2352x1568px, color fundus image
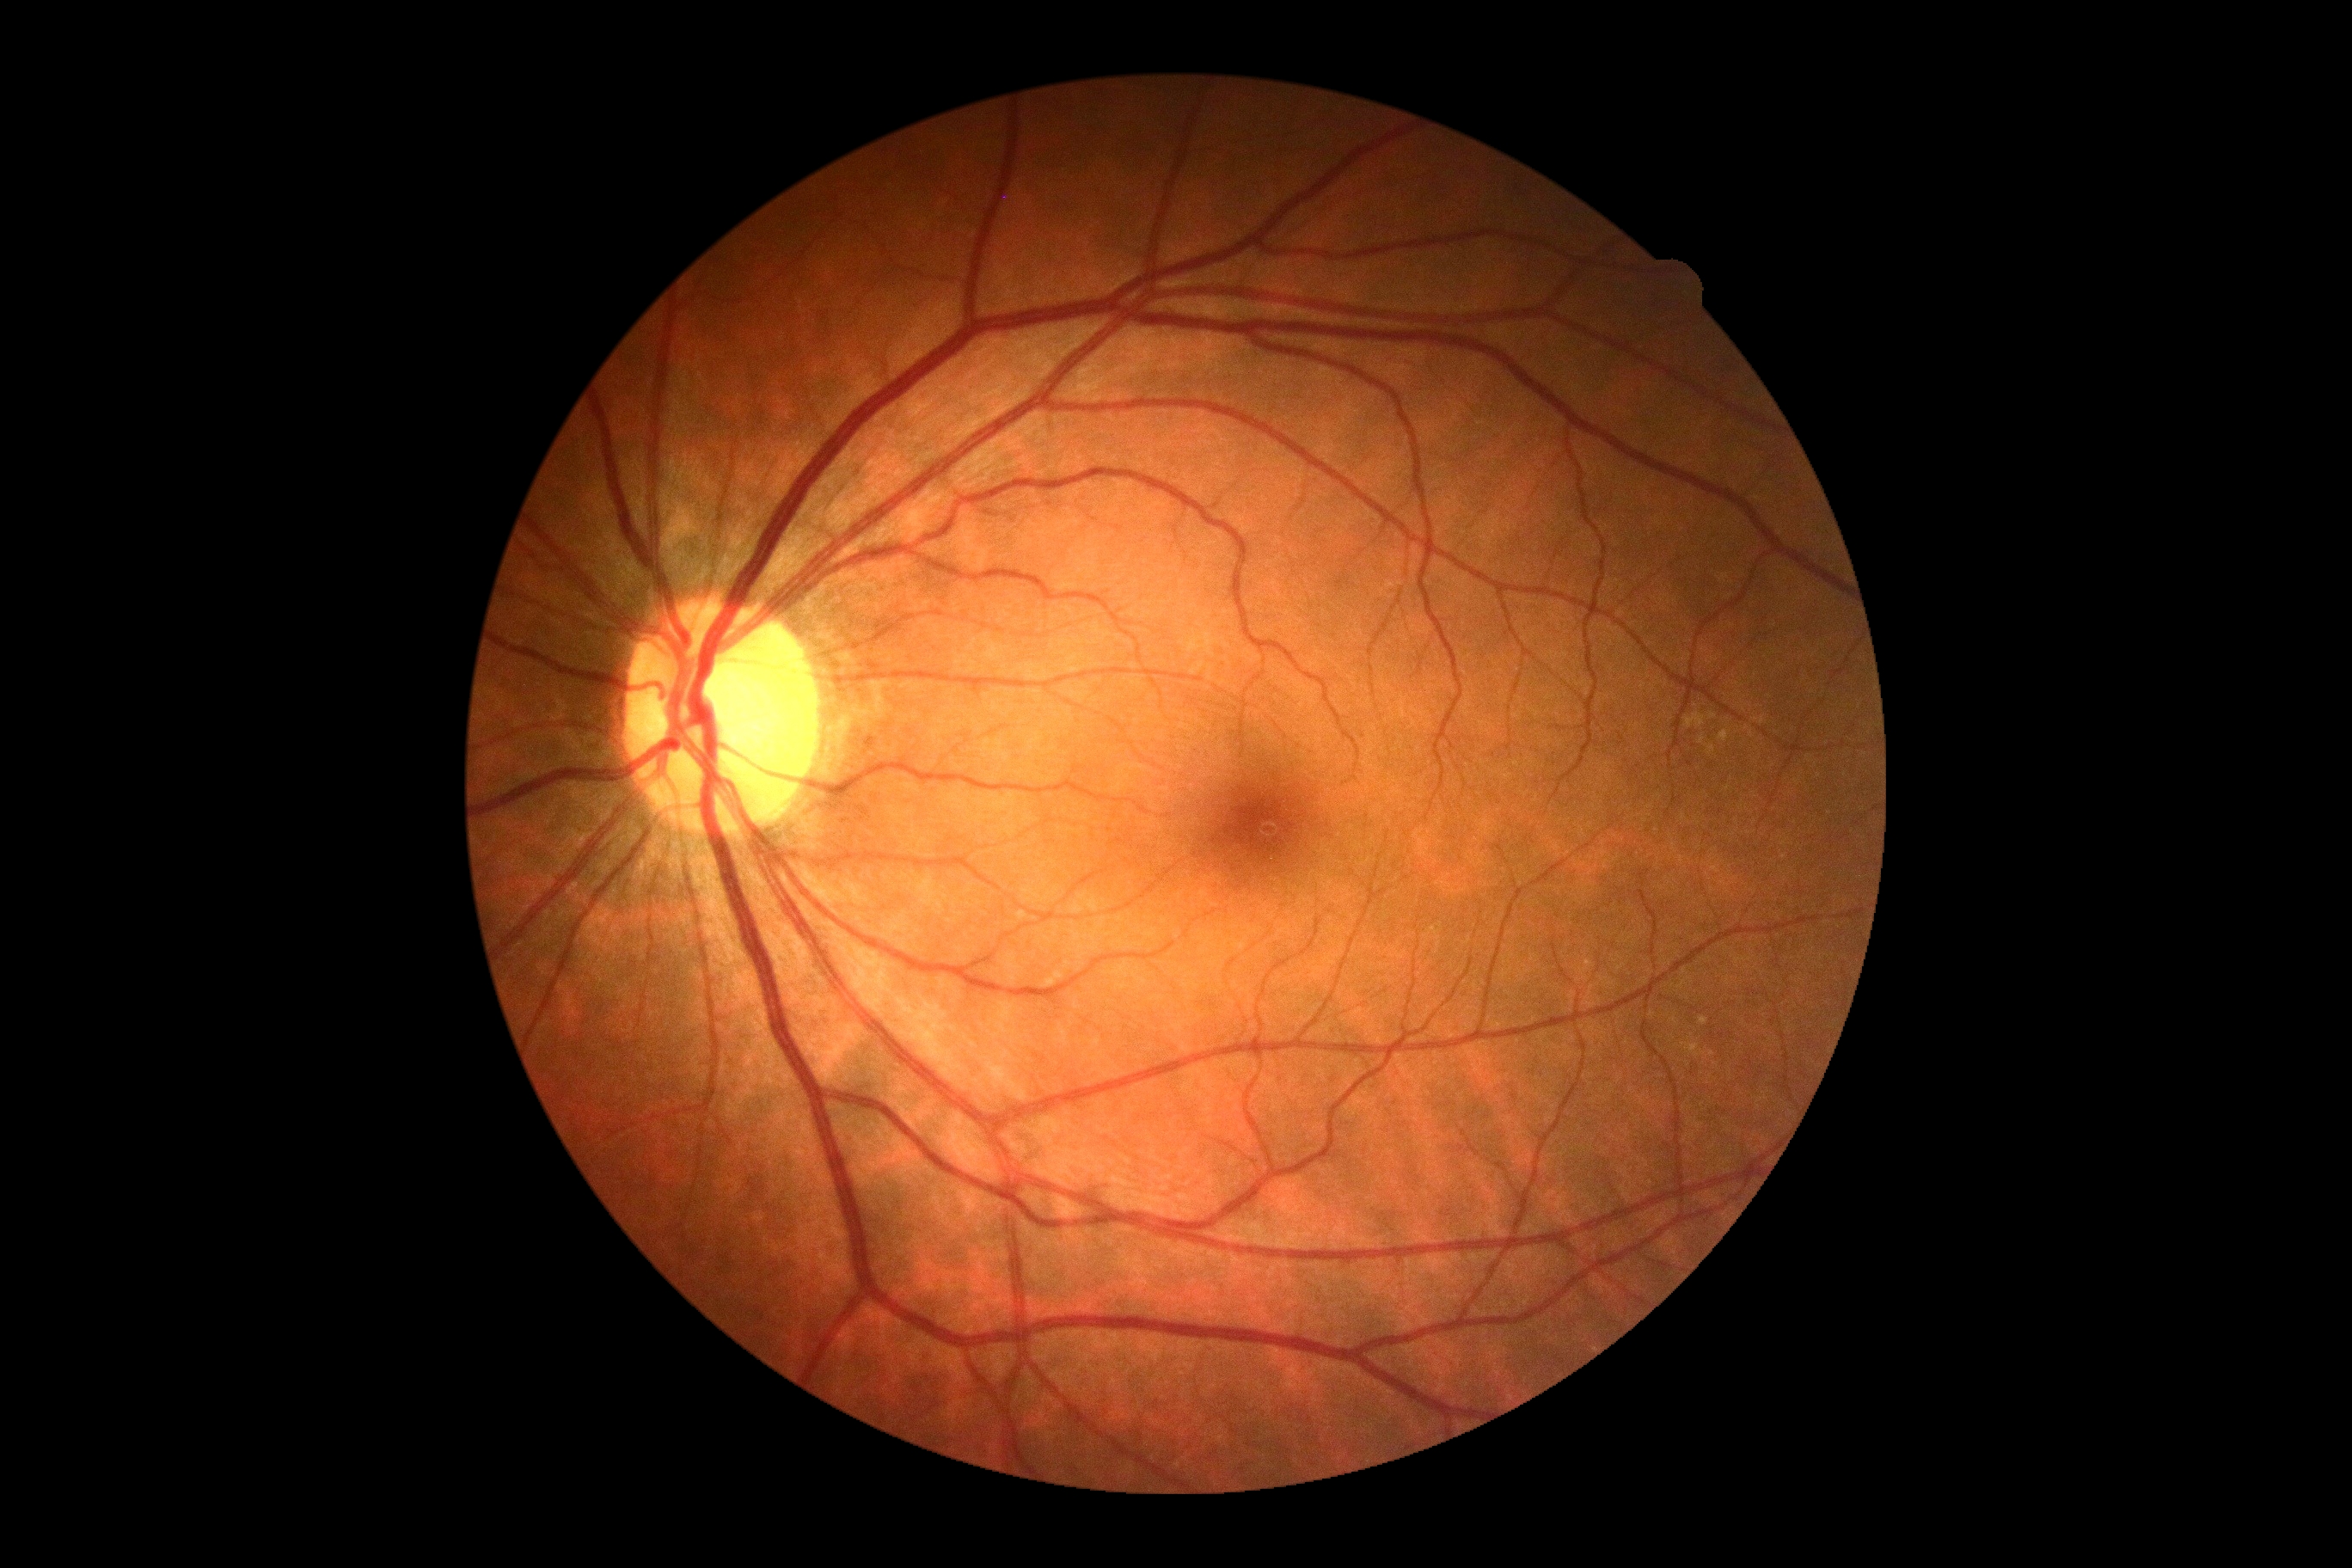
Diabetic retinopathy (DR) is no apparent retinopathy (grade 0) — no visible signs of diabetic retinopathy.